2352x1568px:
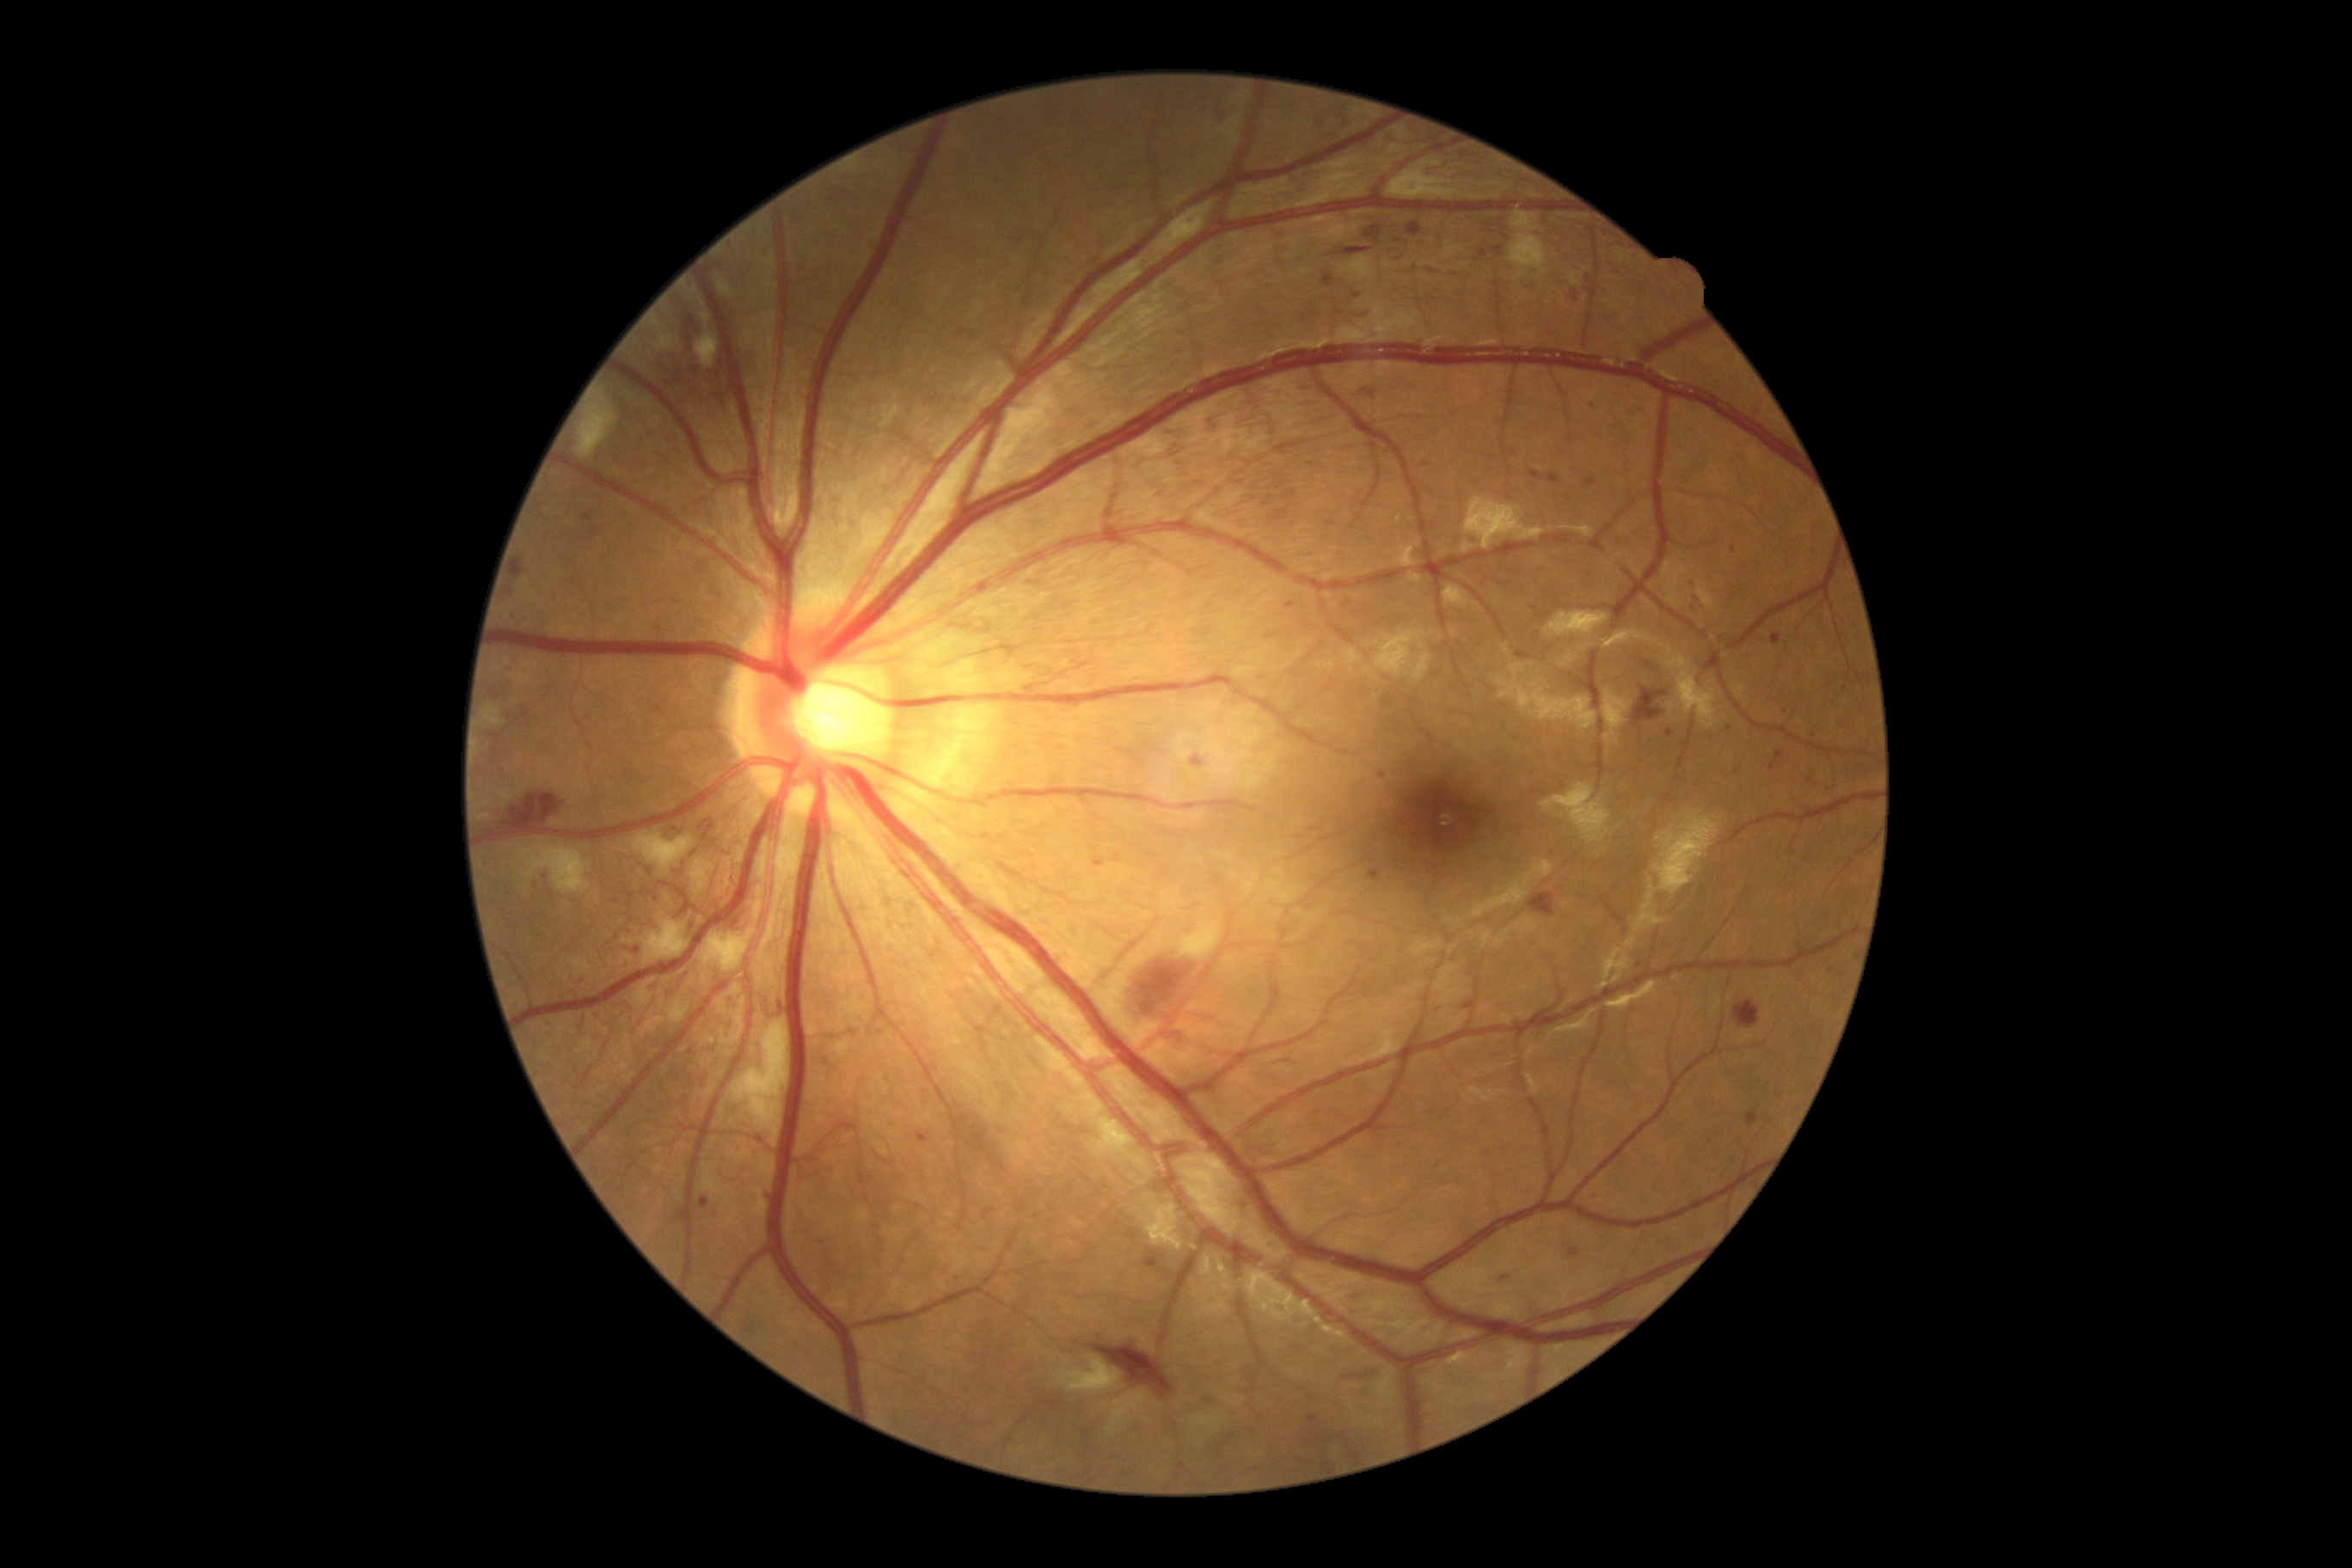
Diabetic retinopathy (DR) is 3/4
Representative lesions:
hemorrhages (HEs) (continued): l=1308, t=553, r=1316, b=561 | l=1165, t=426, r=1187, b=438 | l=1354, t=384, r=1378, b=407 | l=1206, t=415, r=1220, b=432 | l=1483, t=455, r=1495, b=463 | l=1280, t=928, r=1289, b=938 | l=1547, t=474, r=1562, b=484 | l=1586, t=1191, r=1602, b=1203 | l=1182, t=924, r=1197, b=936 | l=1290, t=169, r=1330, b=197 | l=1381, t=450, r=1393, b=460 | l=1285, t=603, r=1294, b=609 | l=539, t=873, r=549, b=883 | l=1270, t=228, r=1287, b=240
Additional small HEs near x=1671, y=735 | x=1779, y=1096 | x=692, y=926 | x=1729, y=728 | x=1593, y=406